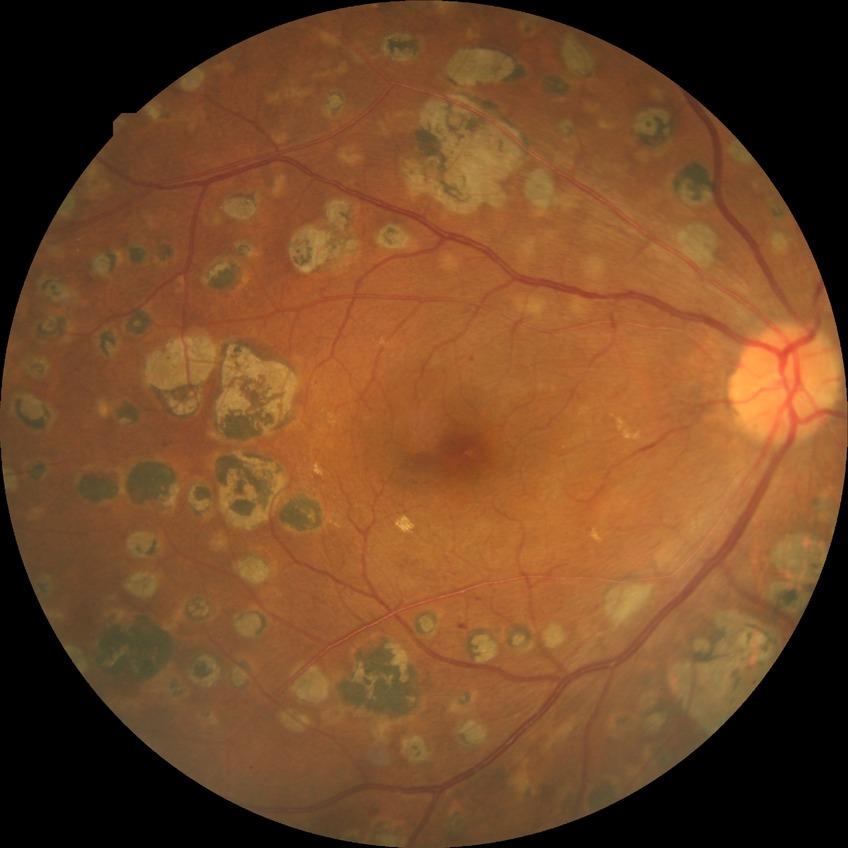

Modified Davis classification is proliferative diabetic retinopathy.